Infant wide-field retinal image.
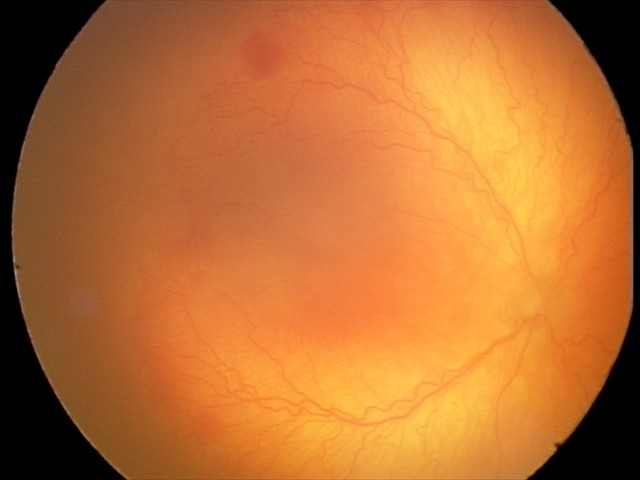 Examination diagnosed as aggressive retinopathy of prematurity.